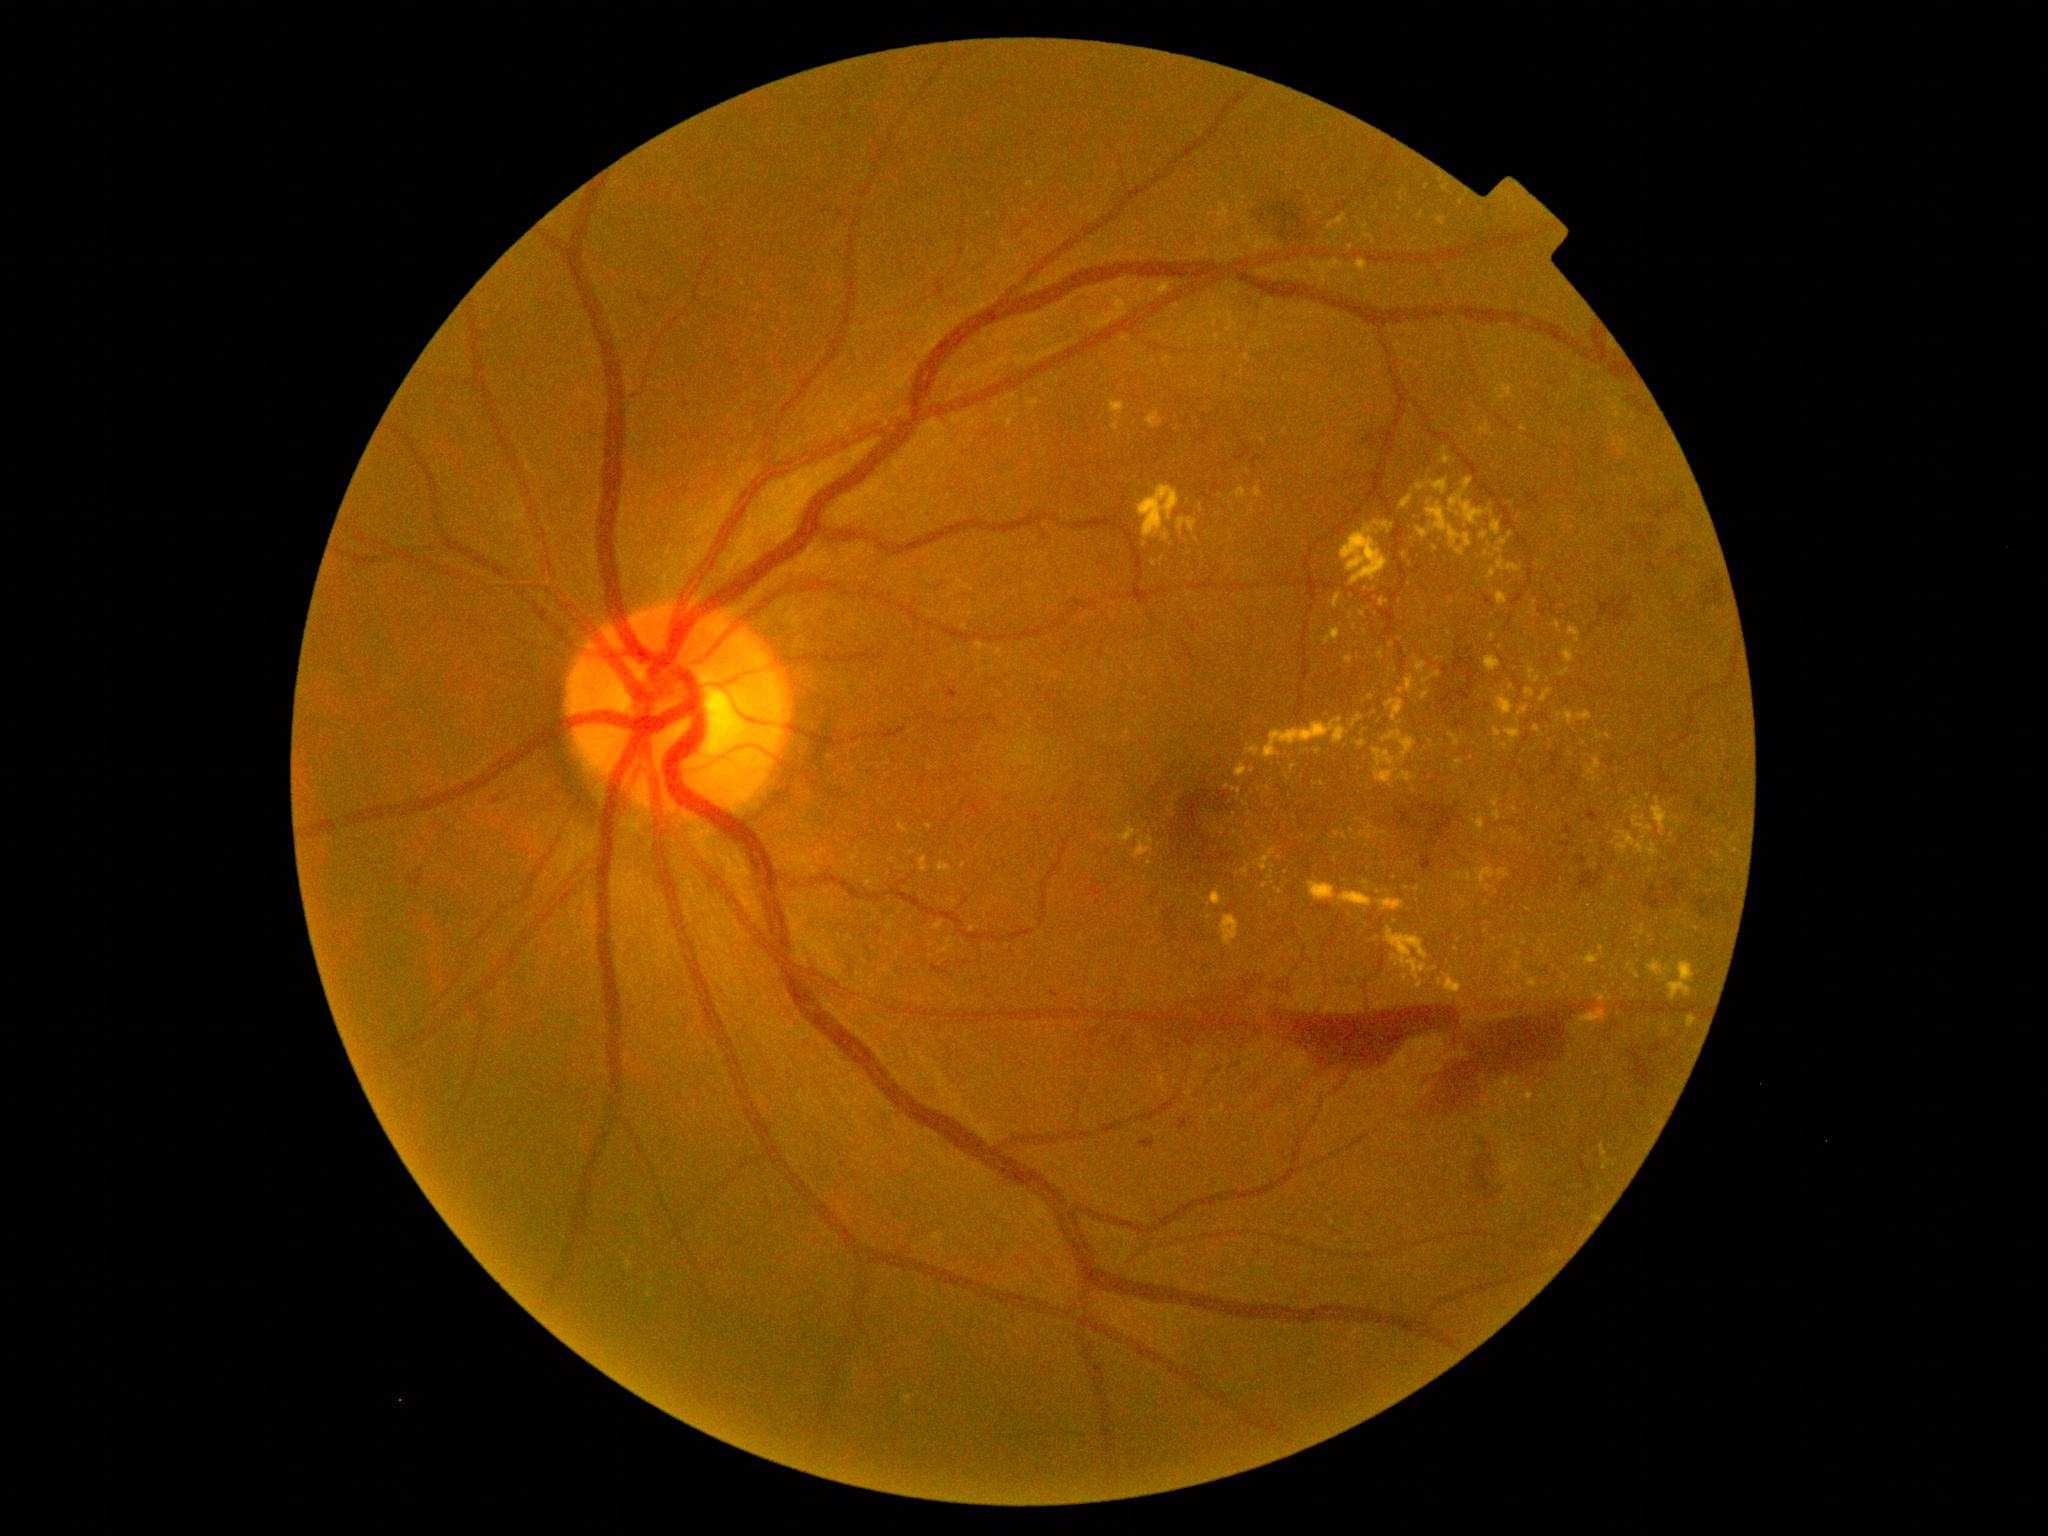

<lesions partial="true">
  <dr_grade>4</dr_grade>
  <ex partial="true">[1221, 916, 1239, 947]; [1494, 729, 1502, 737]; [1416, 660, 1426, 673]; [1374, 767, 1394, 783]; [1119, 828, 1136, 842]; [1492, 521, 1502, 537]; [1480, 425, 1490, 435]; [1489, 570, 1497, 580]</ex>
  <ex_small_approx>(1483,536); (1611,999); (1557,626); (1515,810); (1487,555); (1167,360); (1322,785); (1117,416); (1371,698); (1381,656)</ex_small_approx>
</lesions>